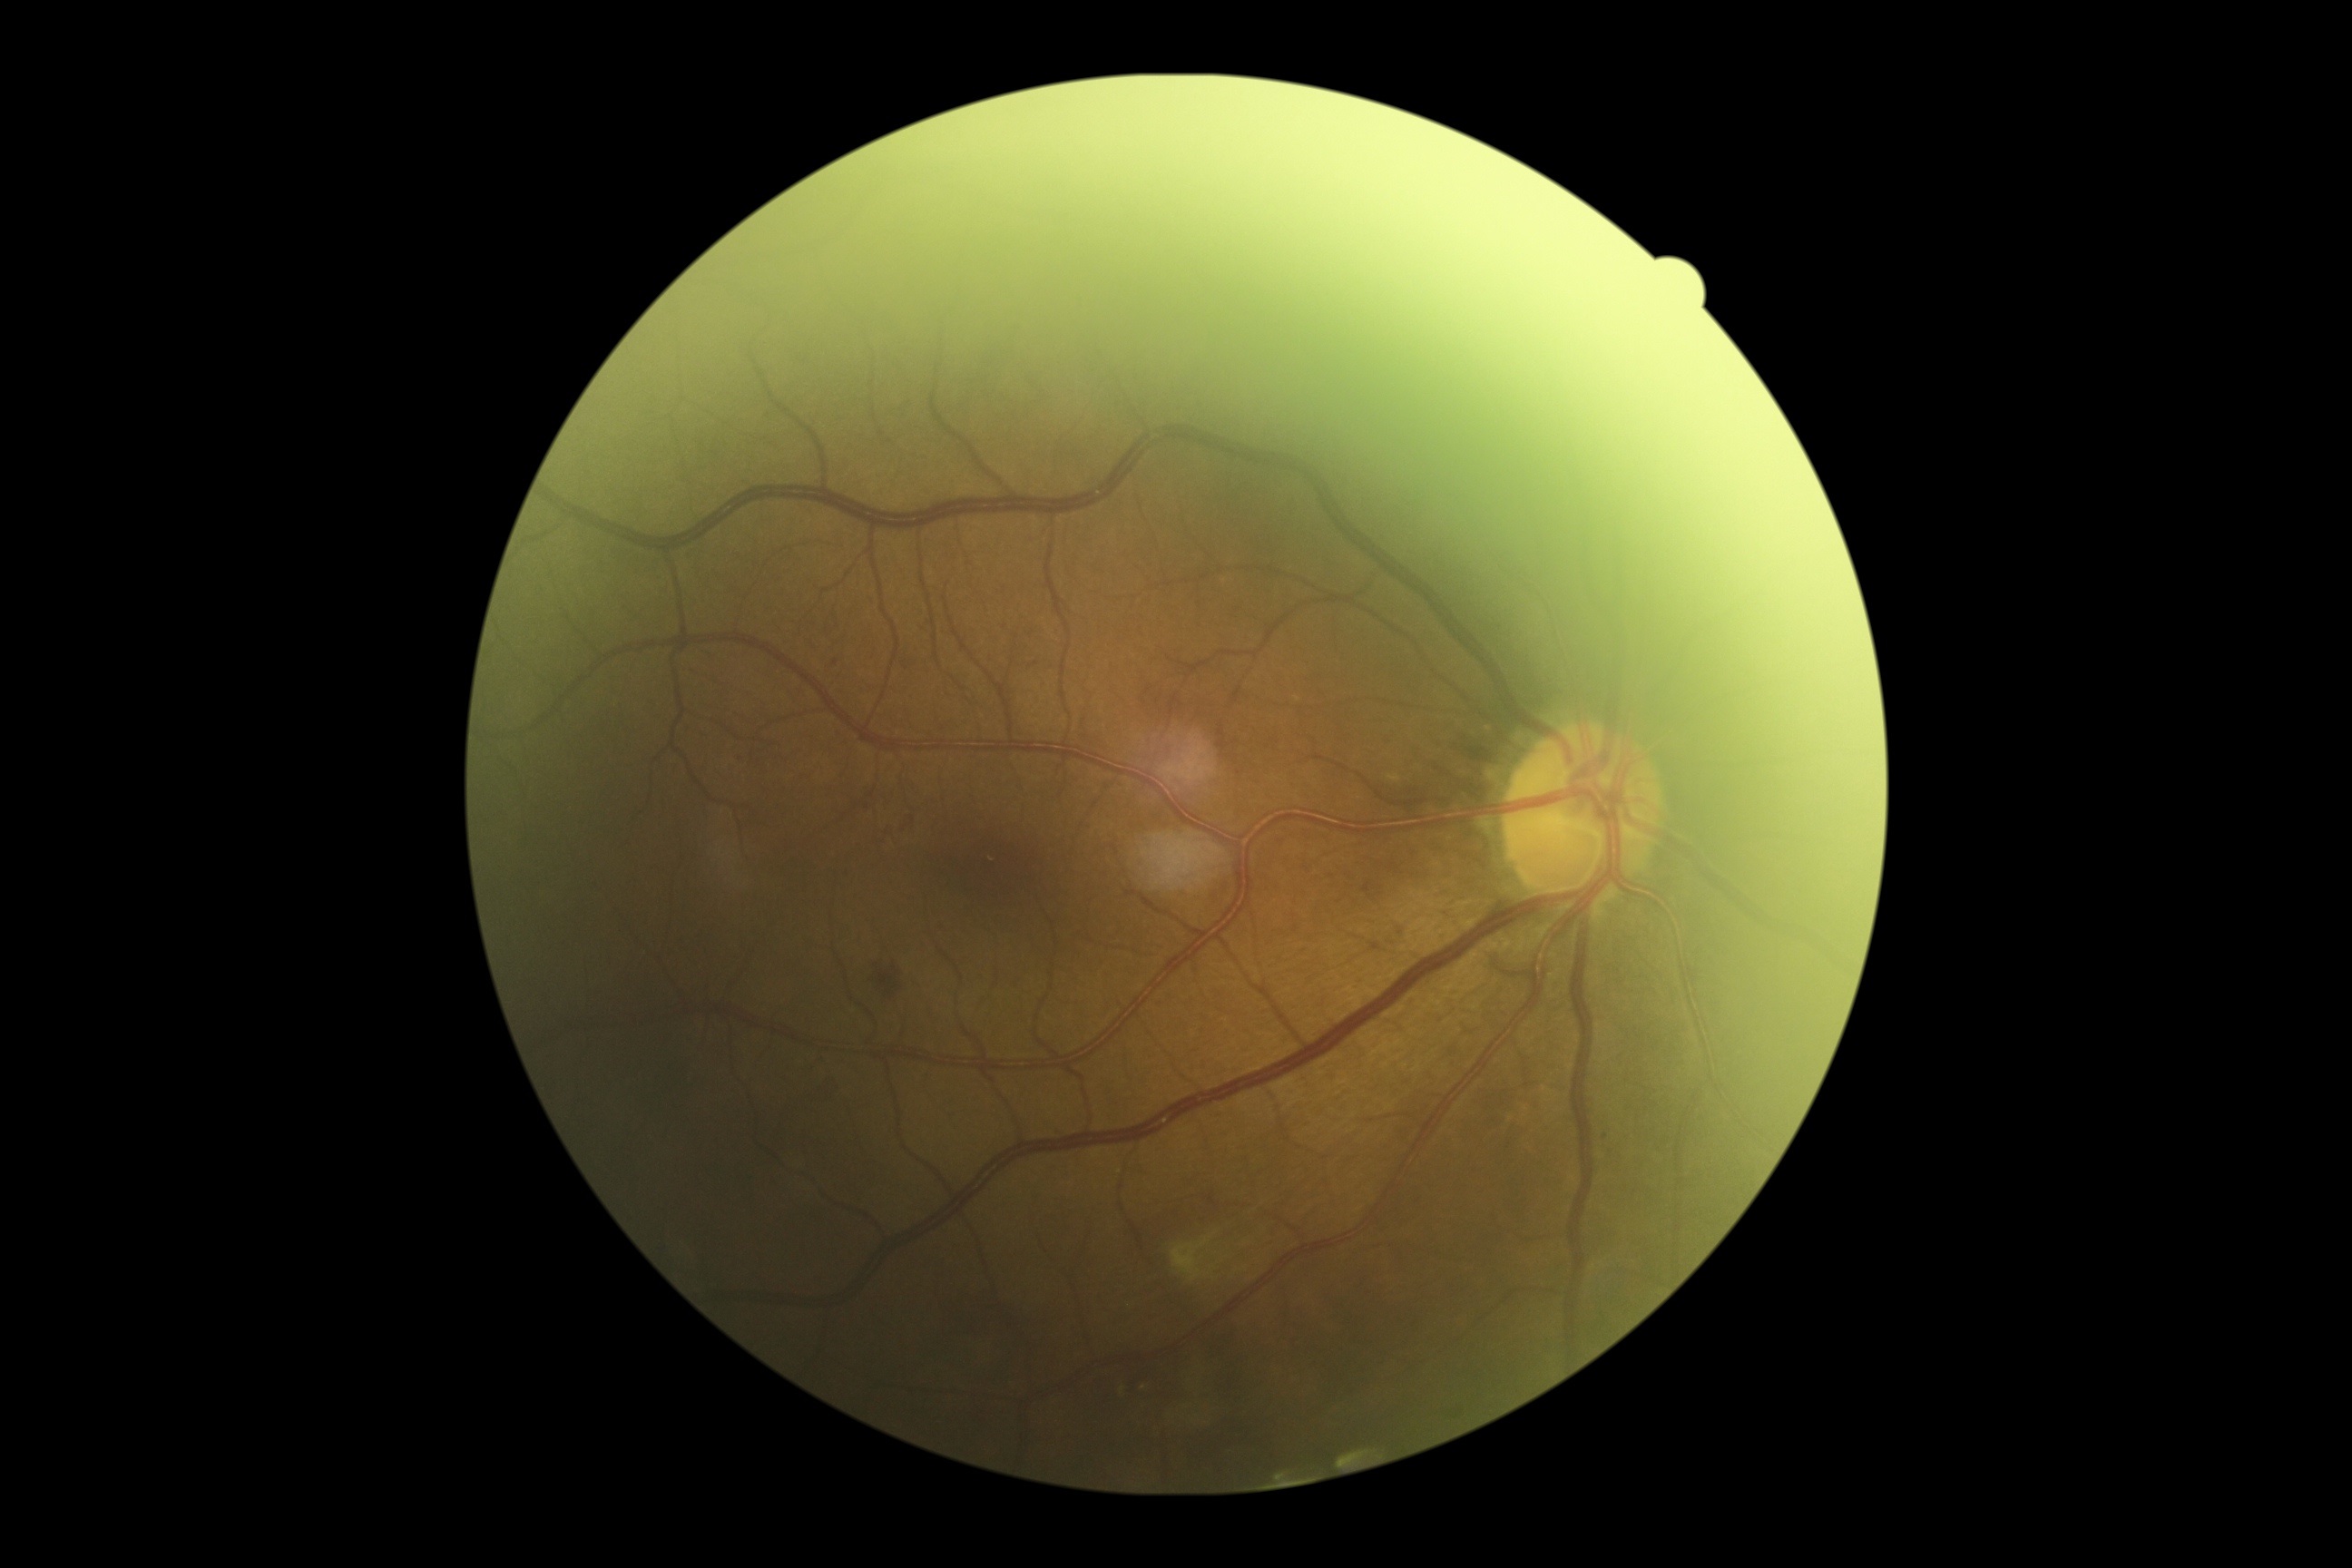
DR severity is grade 2.